Image size 848x848; NIDEK AFC-230; posterior pole color fundus photograph: 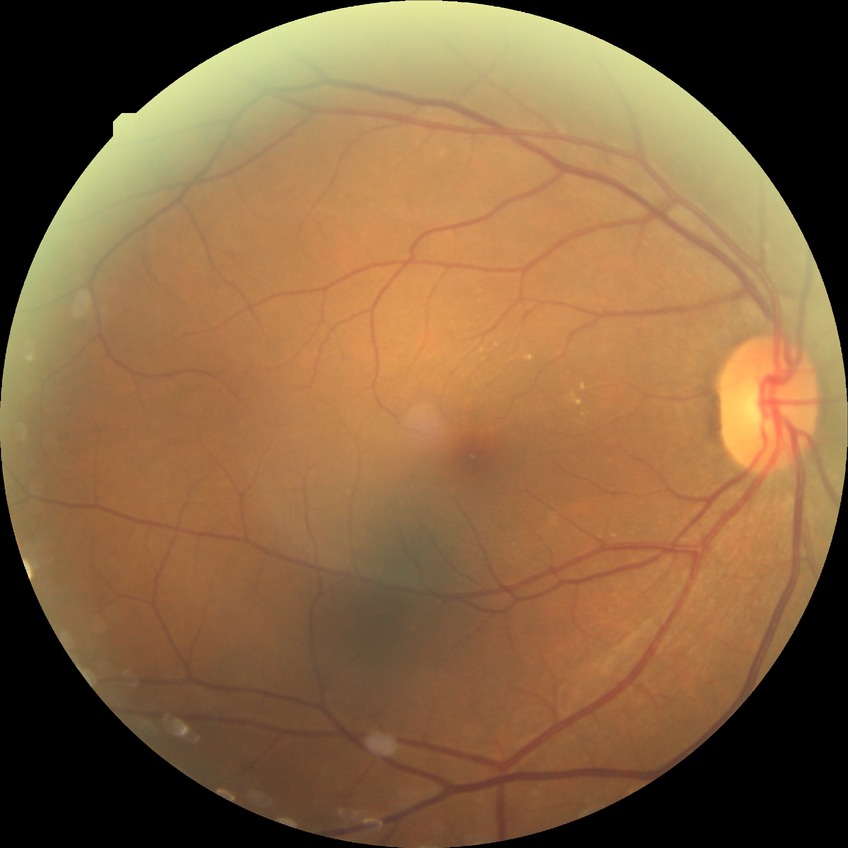 Davis grading is no diabetic retinopathy.